Modified Davis grading:
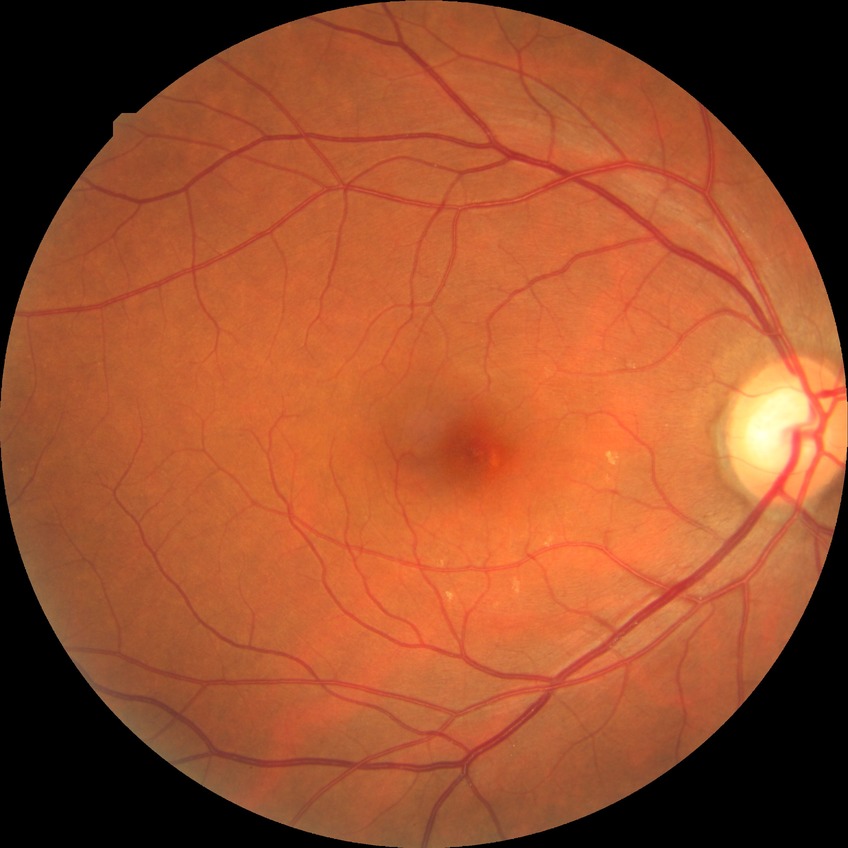 Assessment:
* diabetic retinopathy grade: simple diabetic retinopathy